FOV: 45 degrees, color fundus image
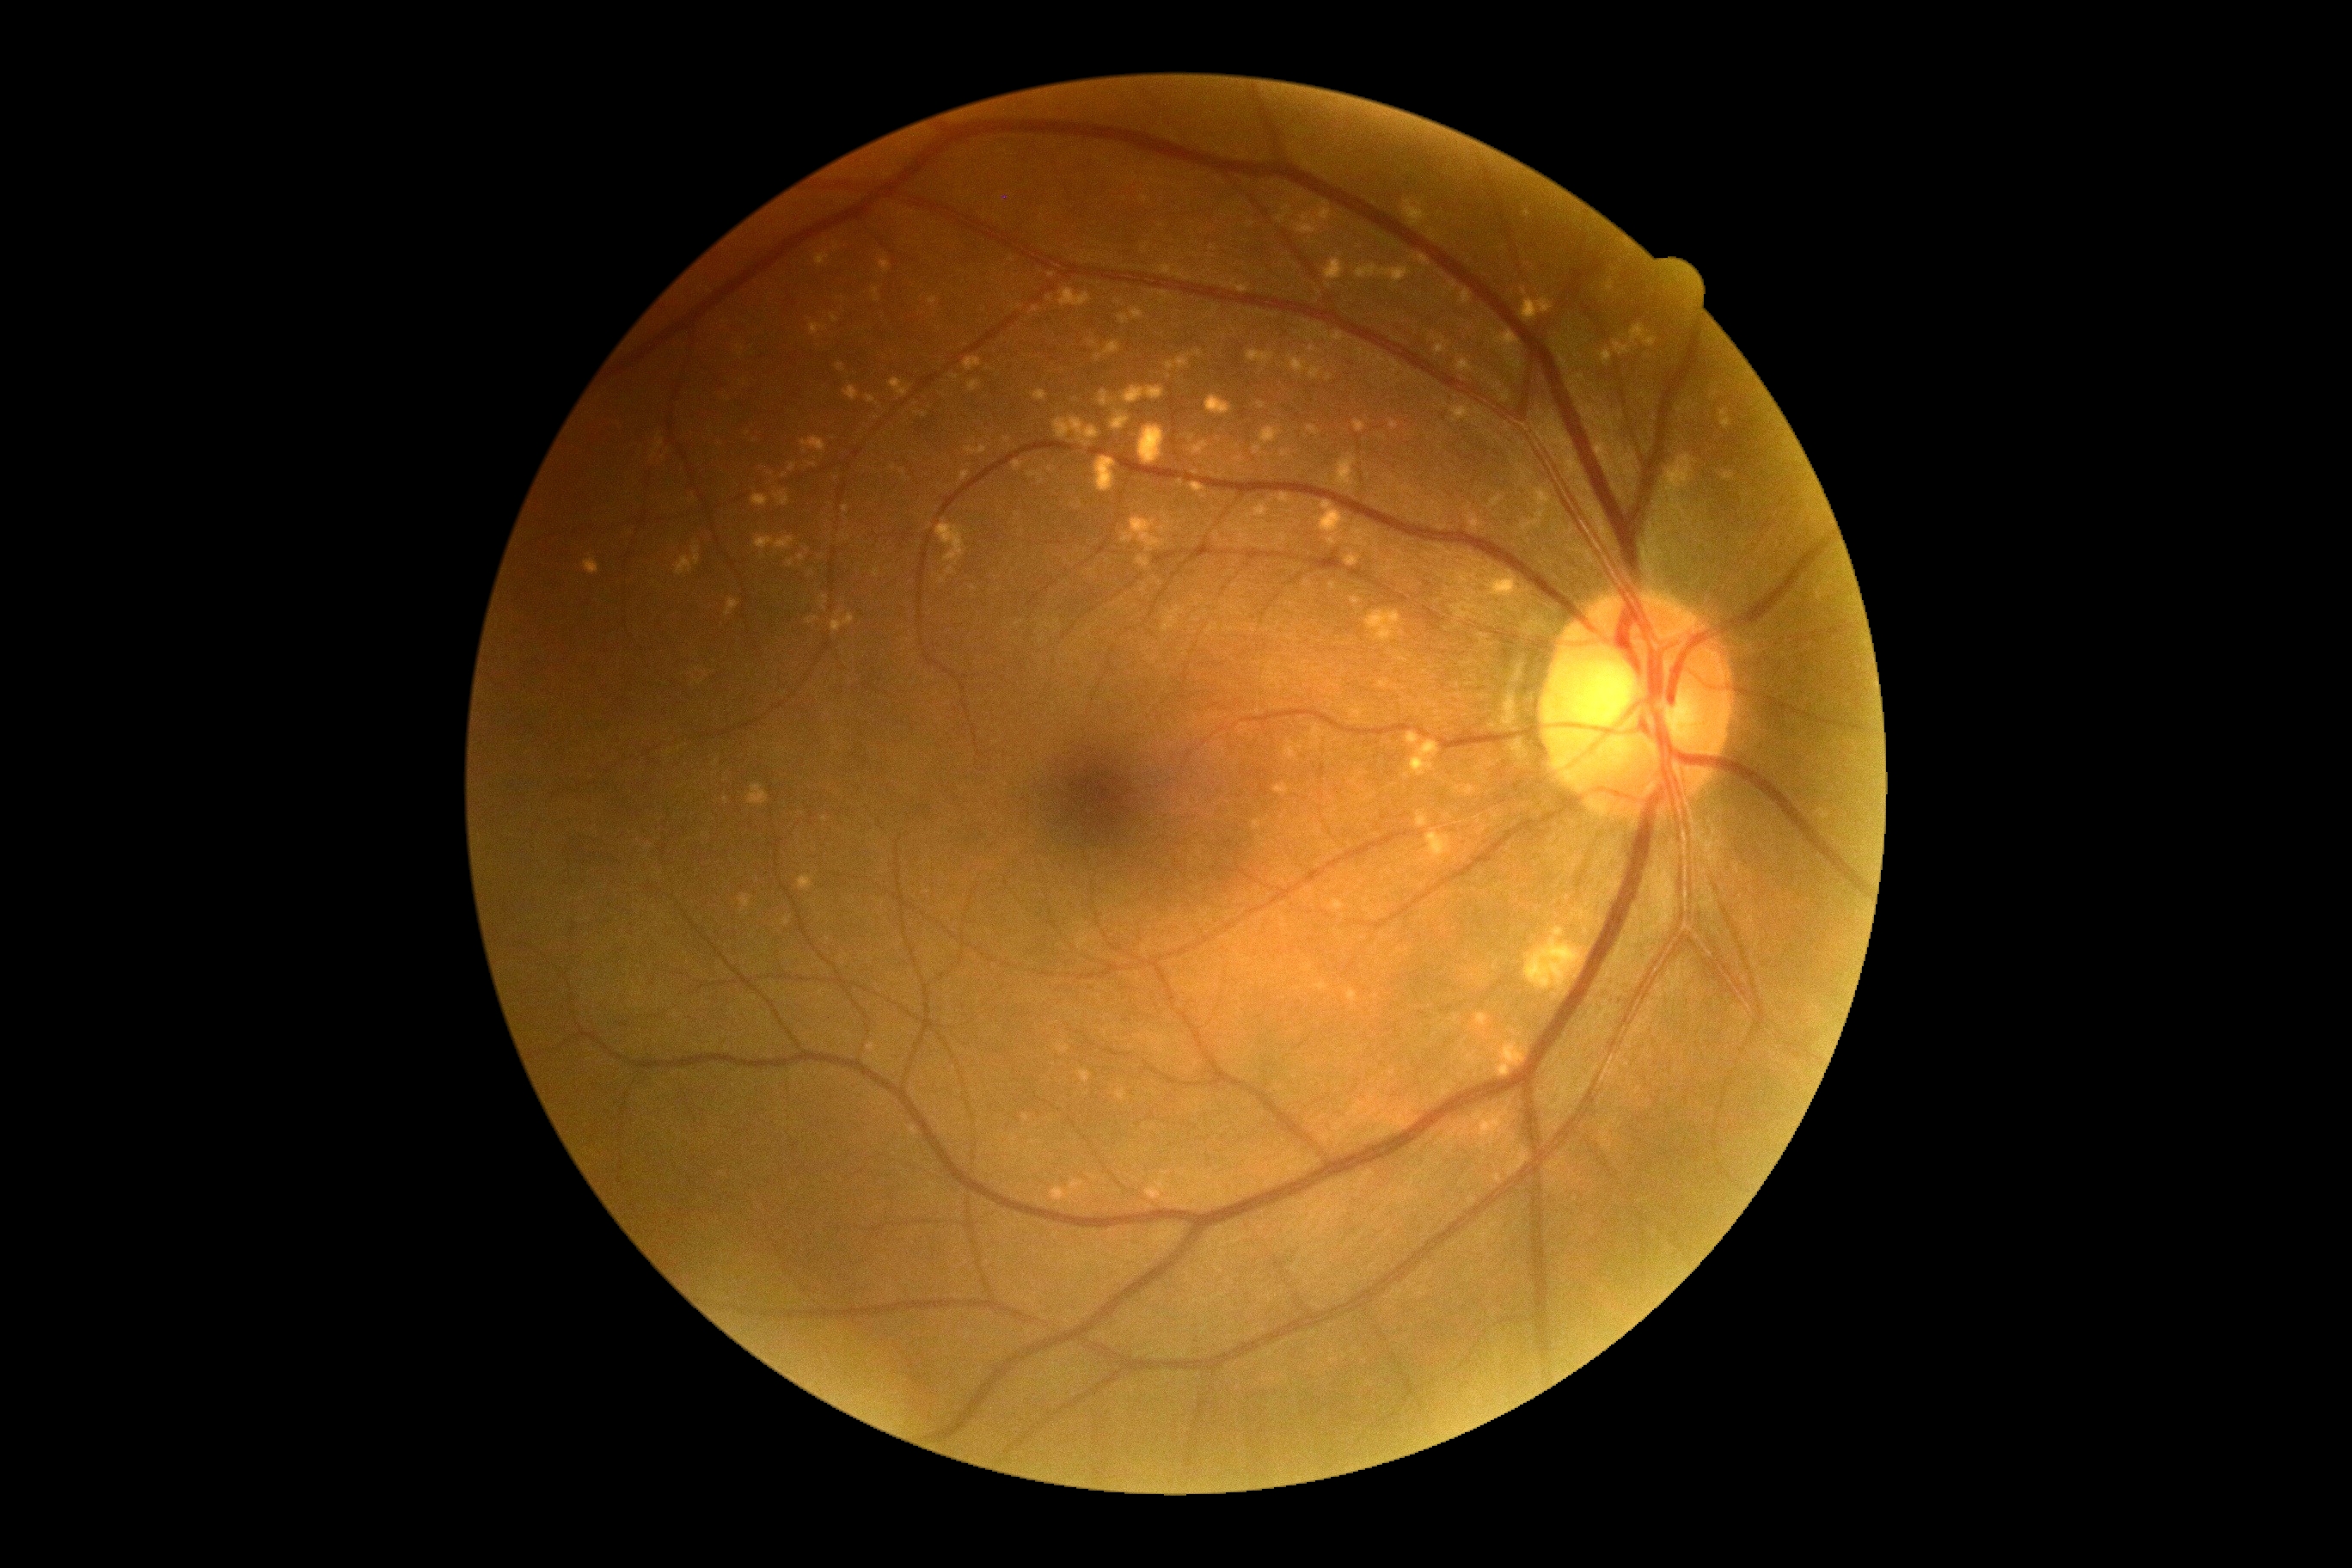 diabetic retinopathy (DR)=grade 0 (no apparent retinopathy).